CFP — 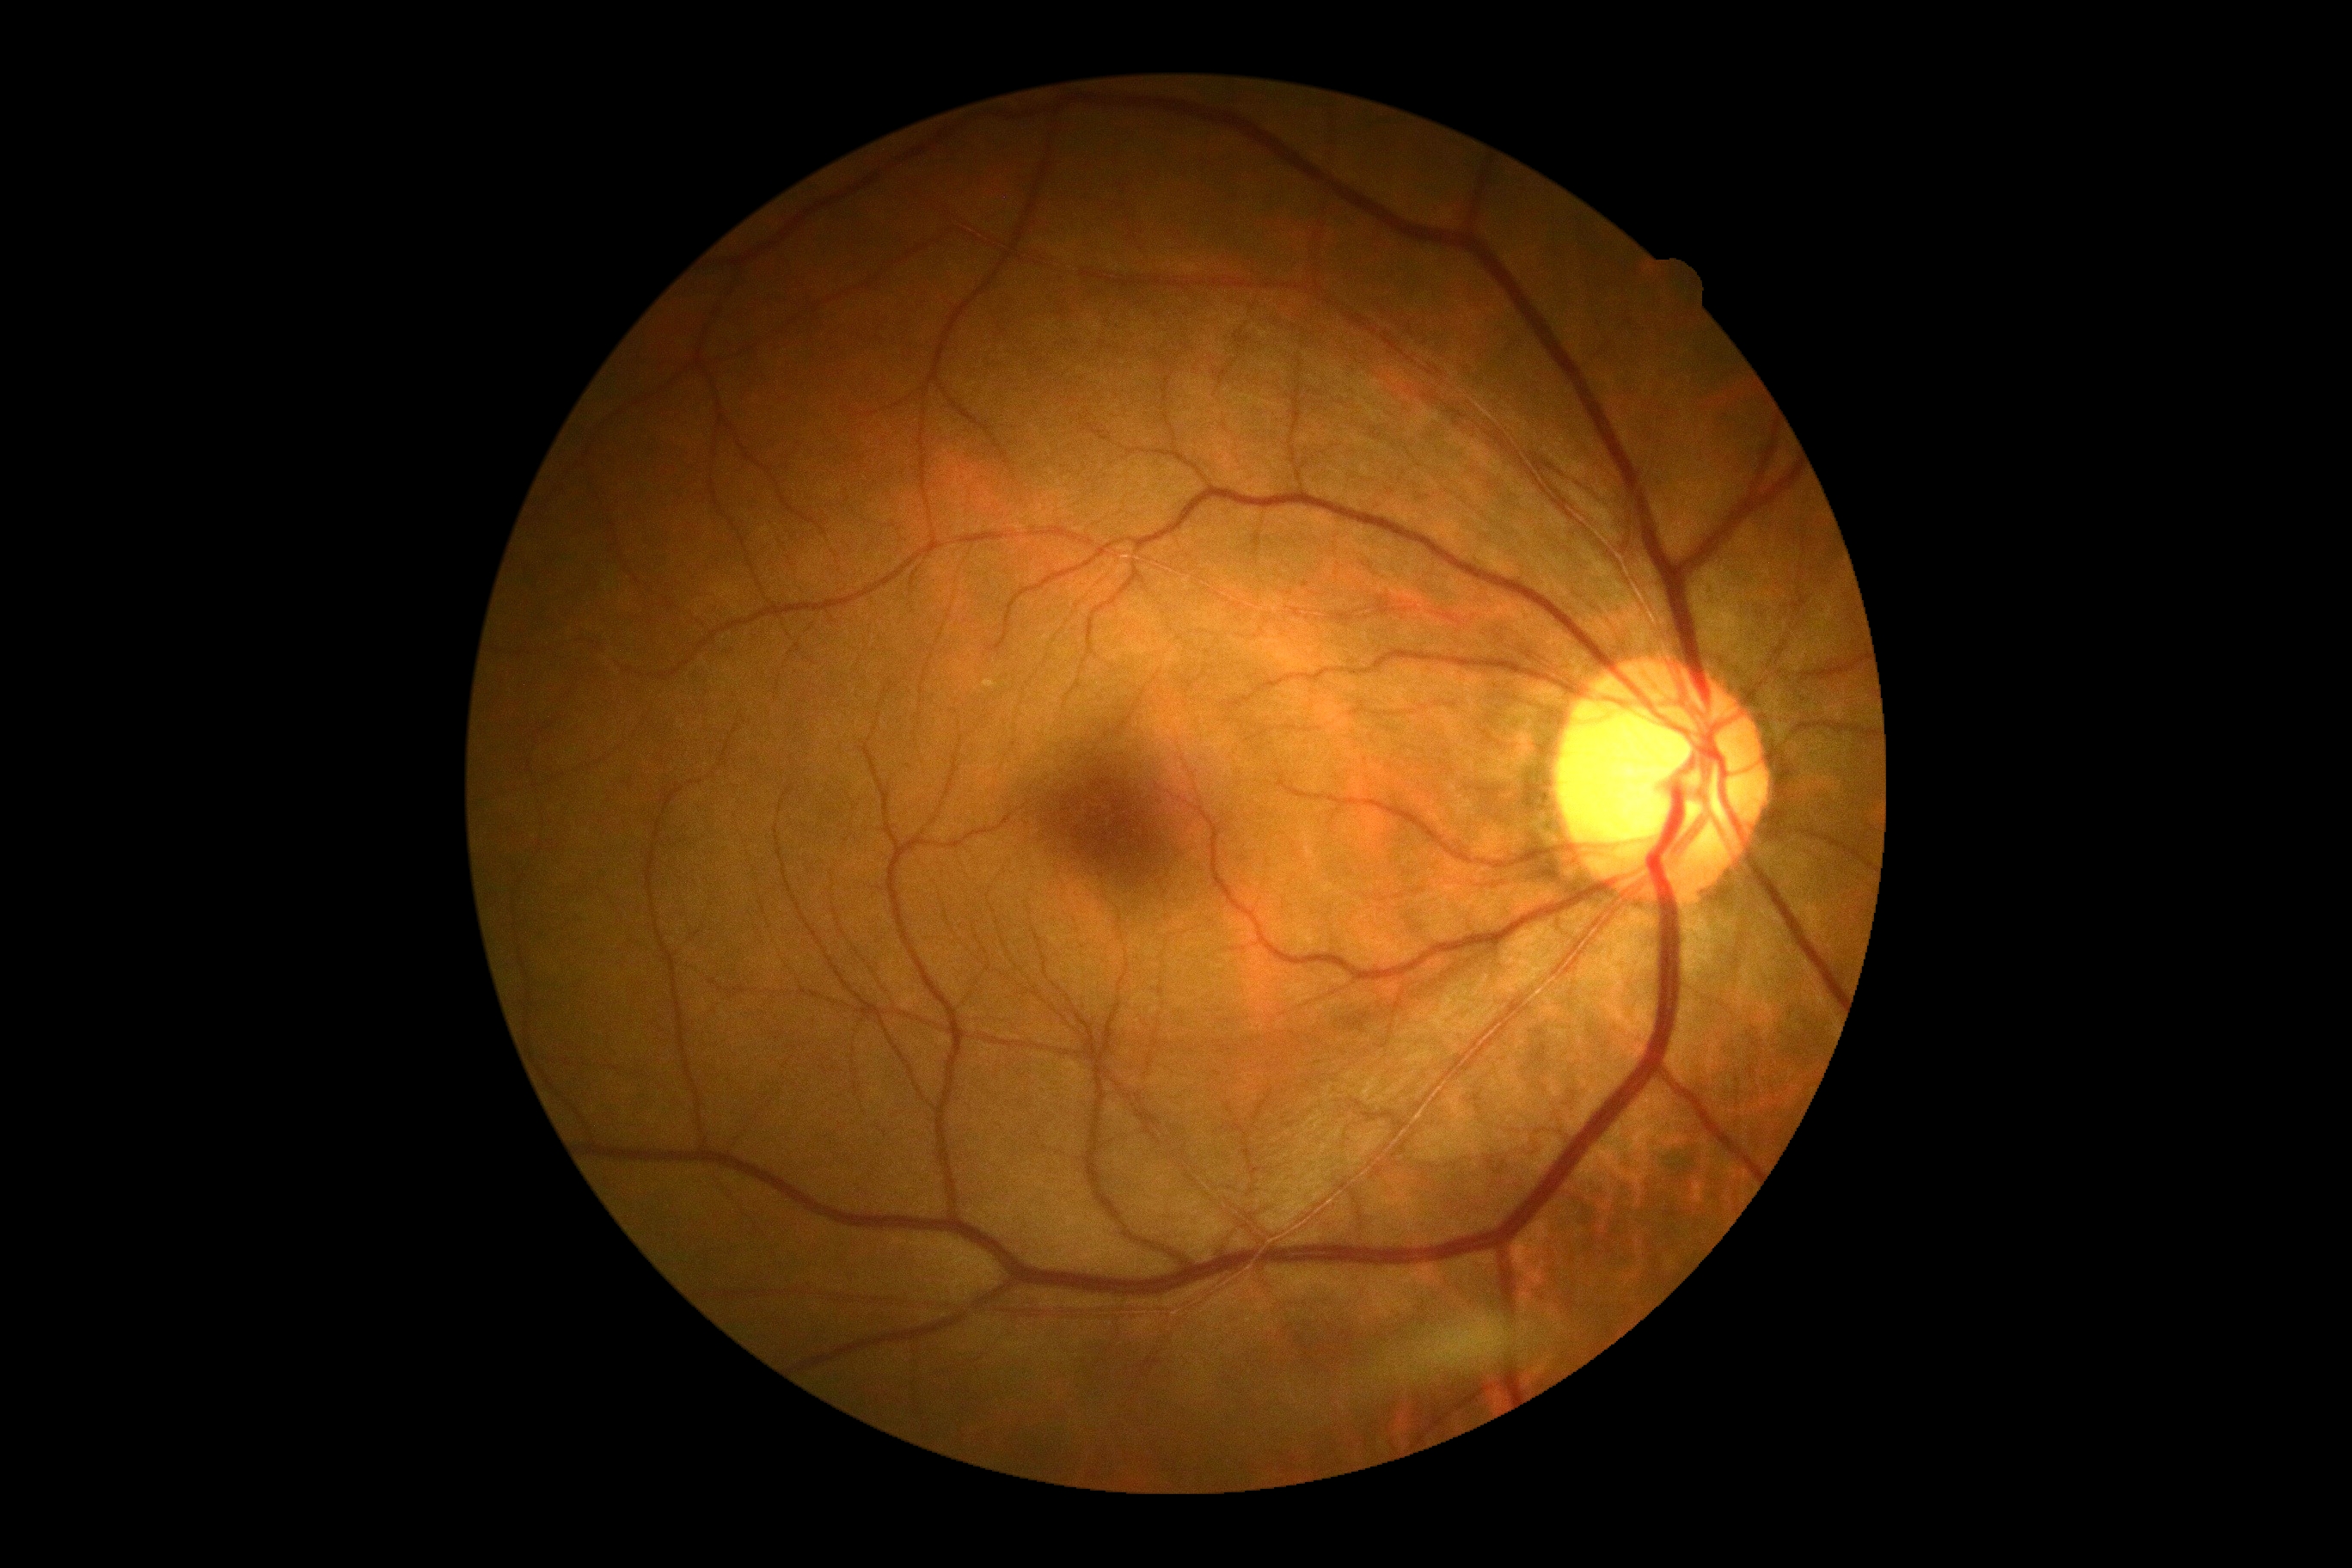

Annotations:
* DR impression — negative for DR
* retinopathy — grade 0 (no apparent retinopathy)